Color fundus image, pupil-dilated, captured on a Topcon TRC-50DX fundus camera
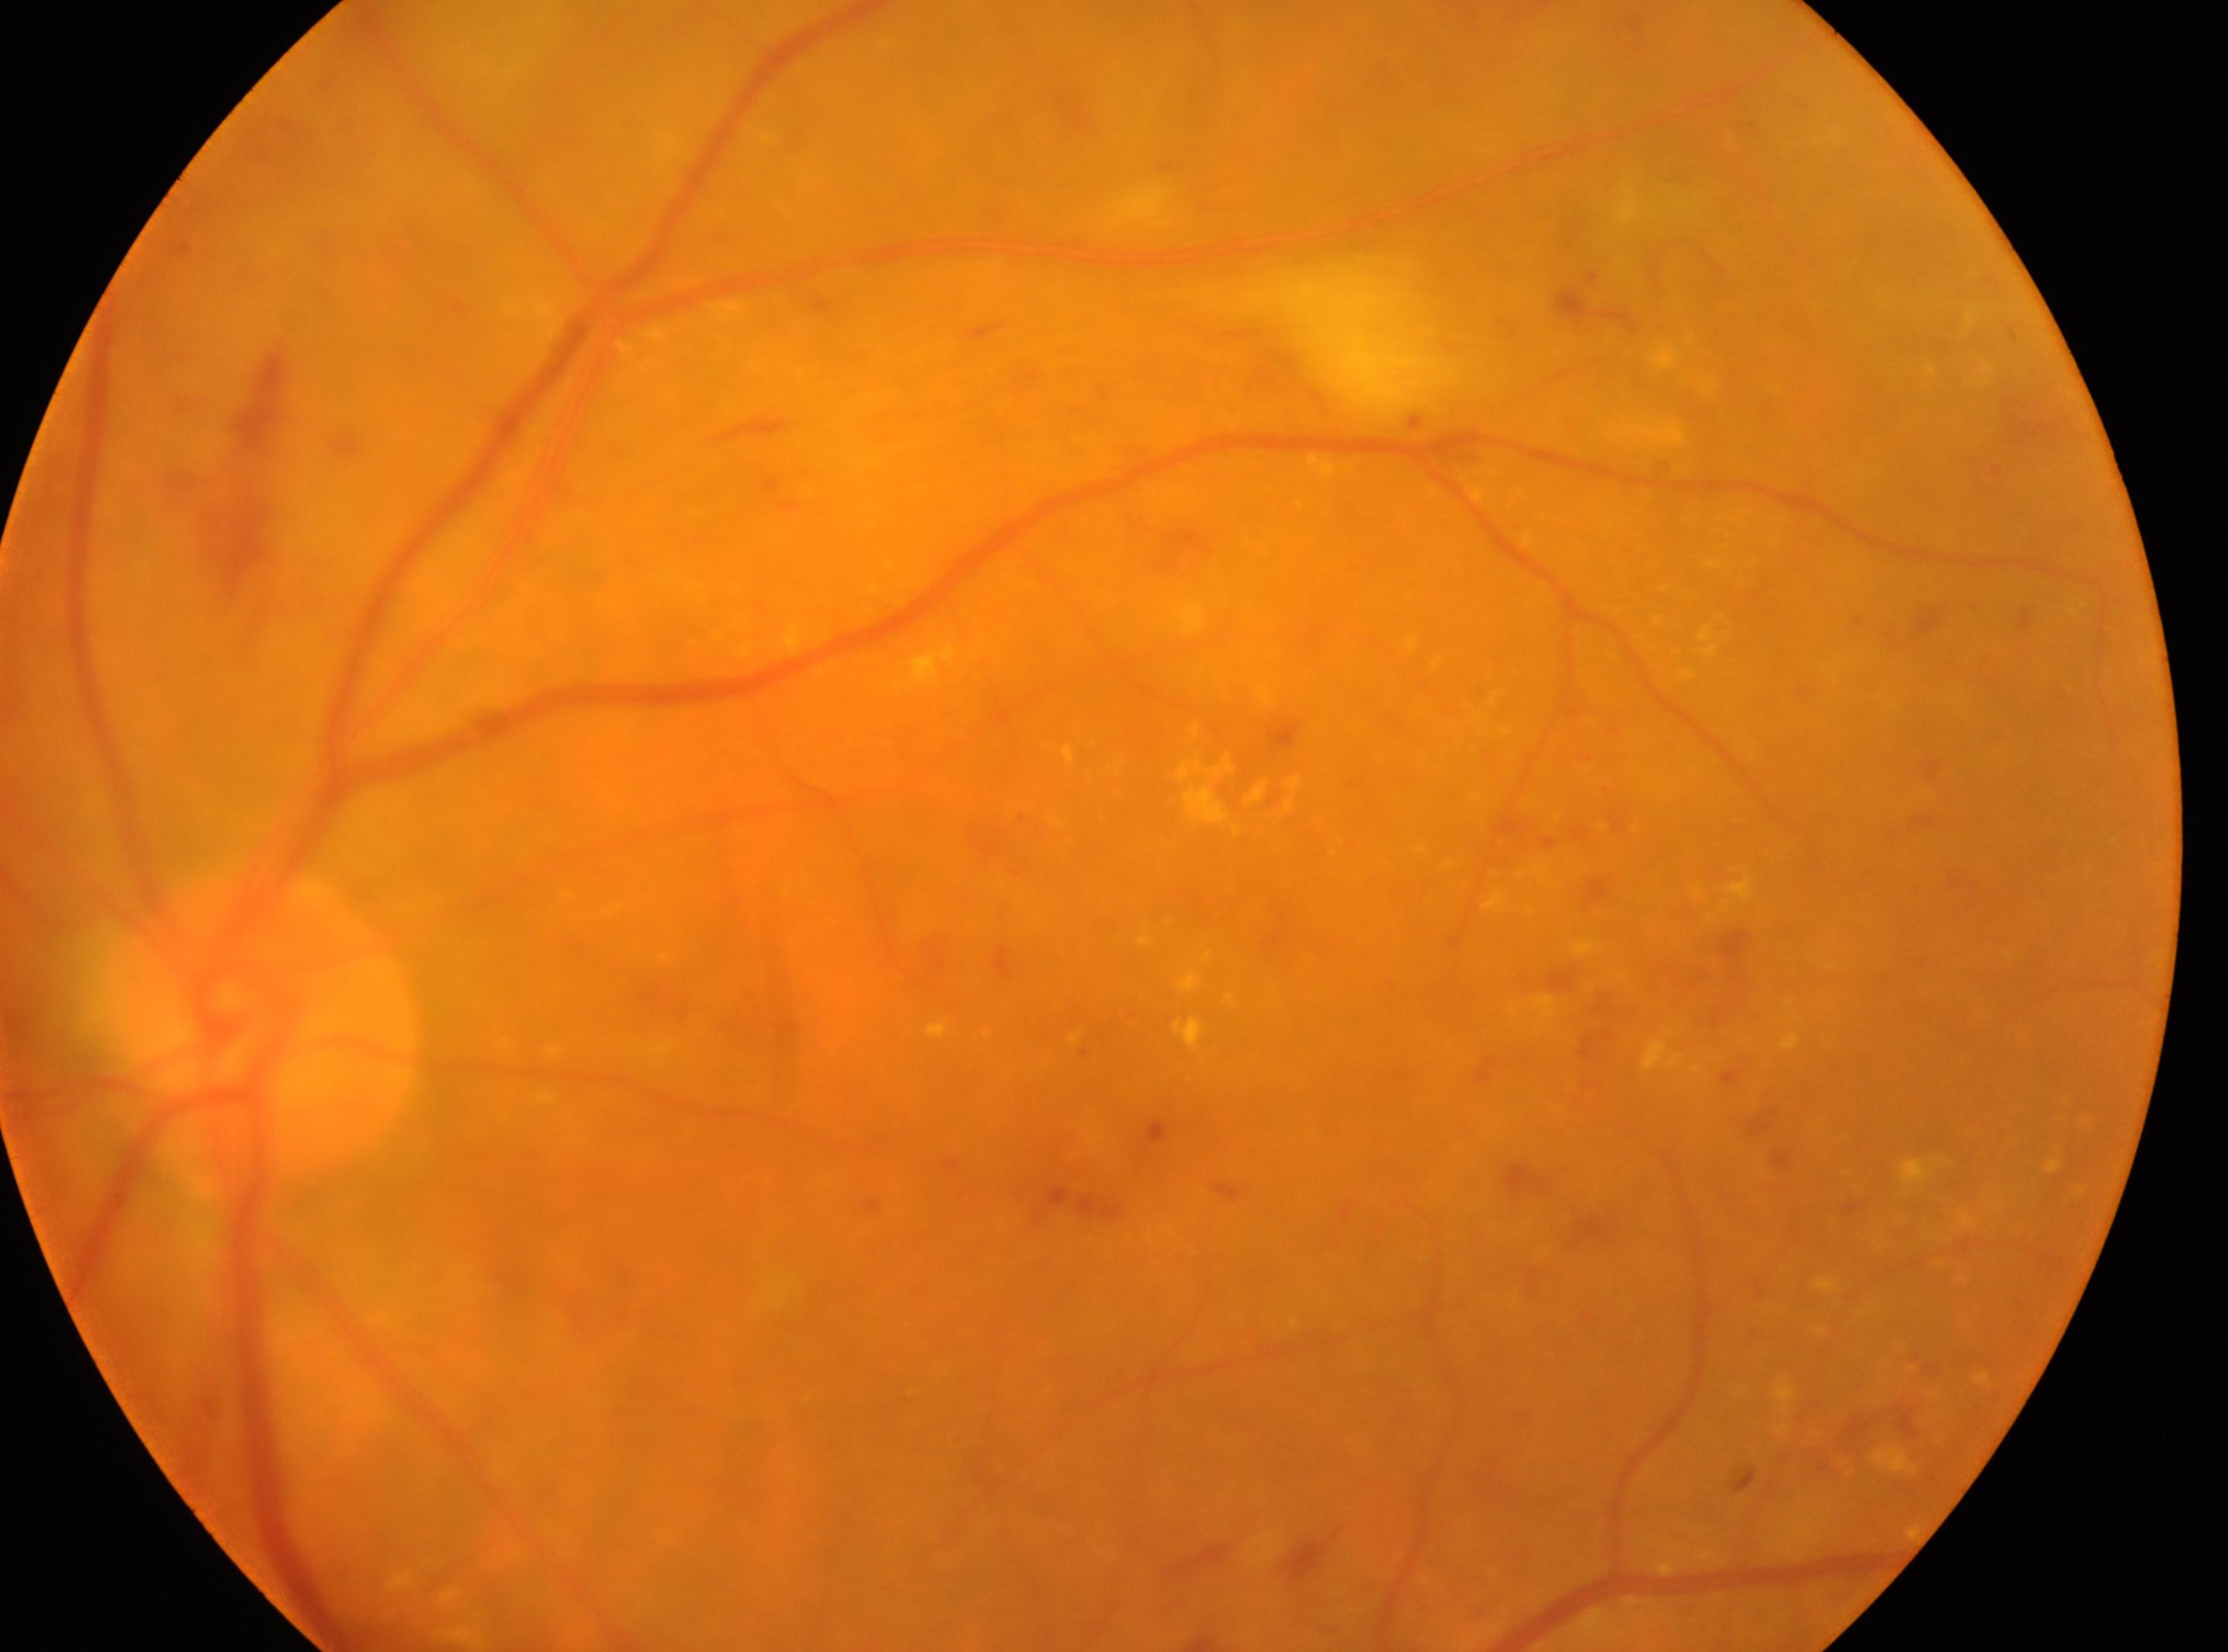

Diabetic retinopathy: grade 2 (moderate NPDR). Eye: oculus sinister. The foveal center is at (x=1095, y=1143). Optic nerve head located at (x=260, y=1029).